45° FOV:
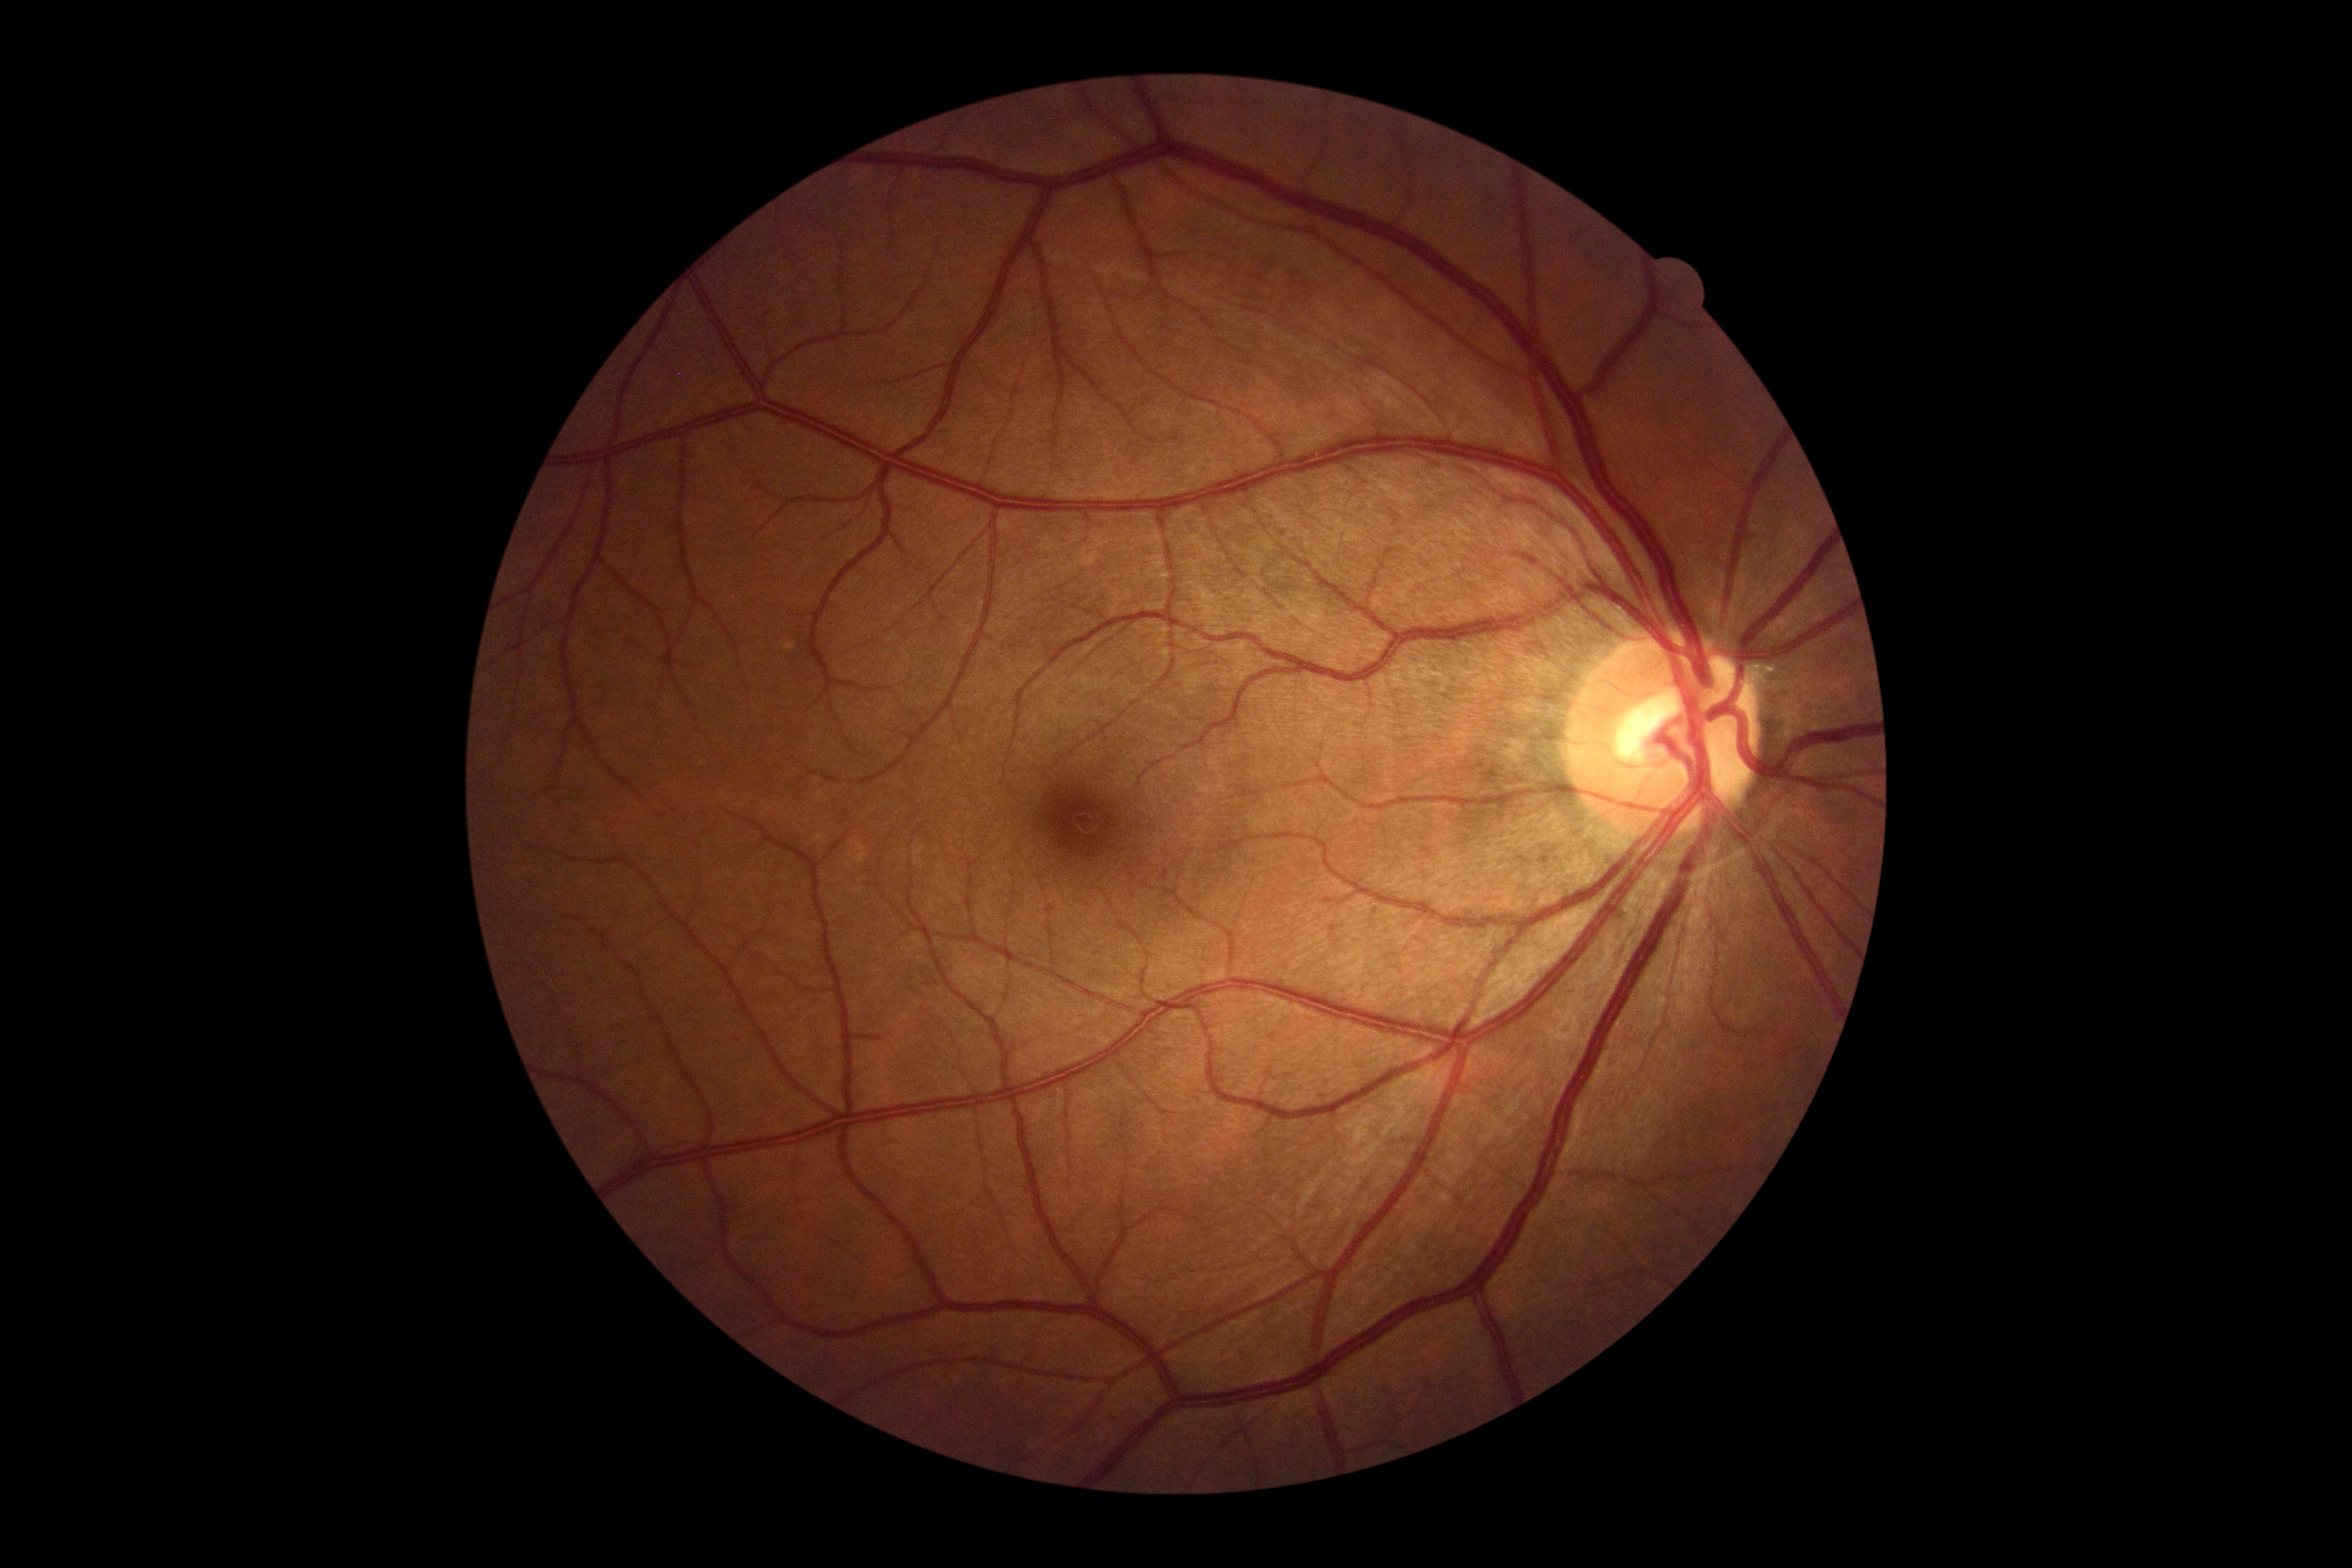
• DR impression — negative for DR
• diabetic retinopathy grade — 0/4